Graded on the modified Davis scale:
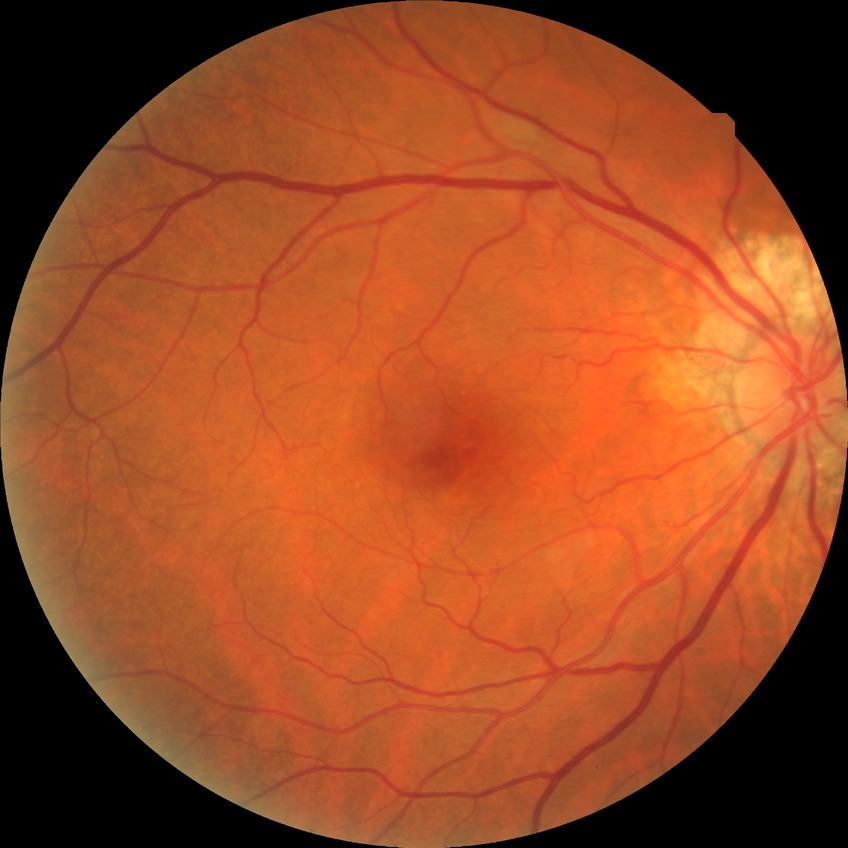

Davis DR grade: NDR.